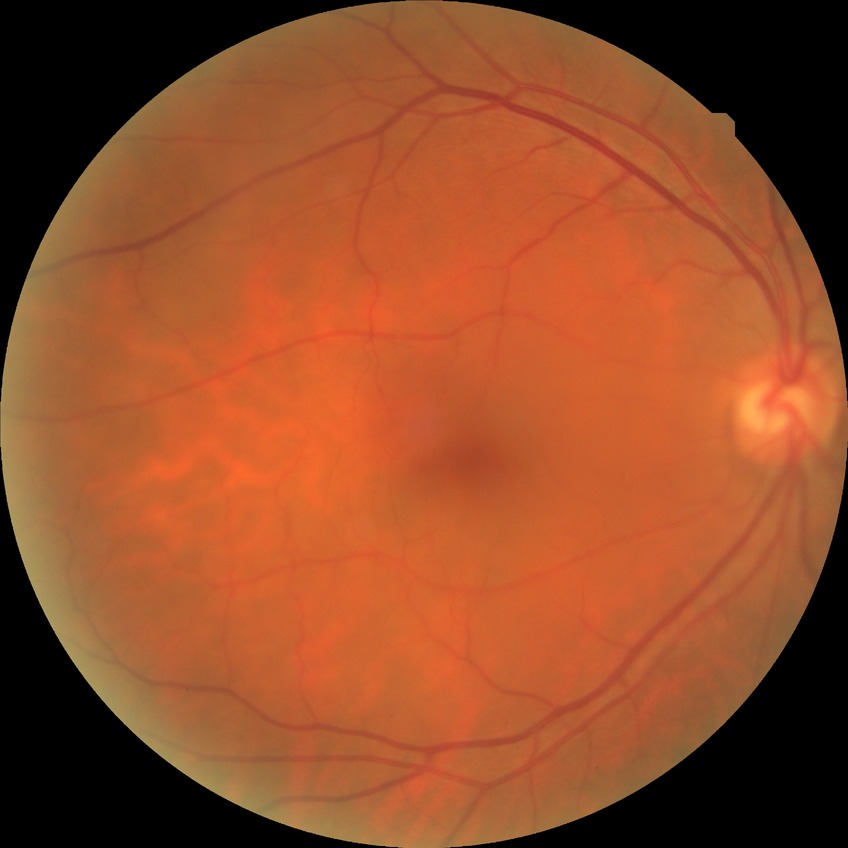

Assessment:
- retinopathy stage — no diabetic retinopathy